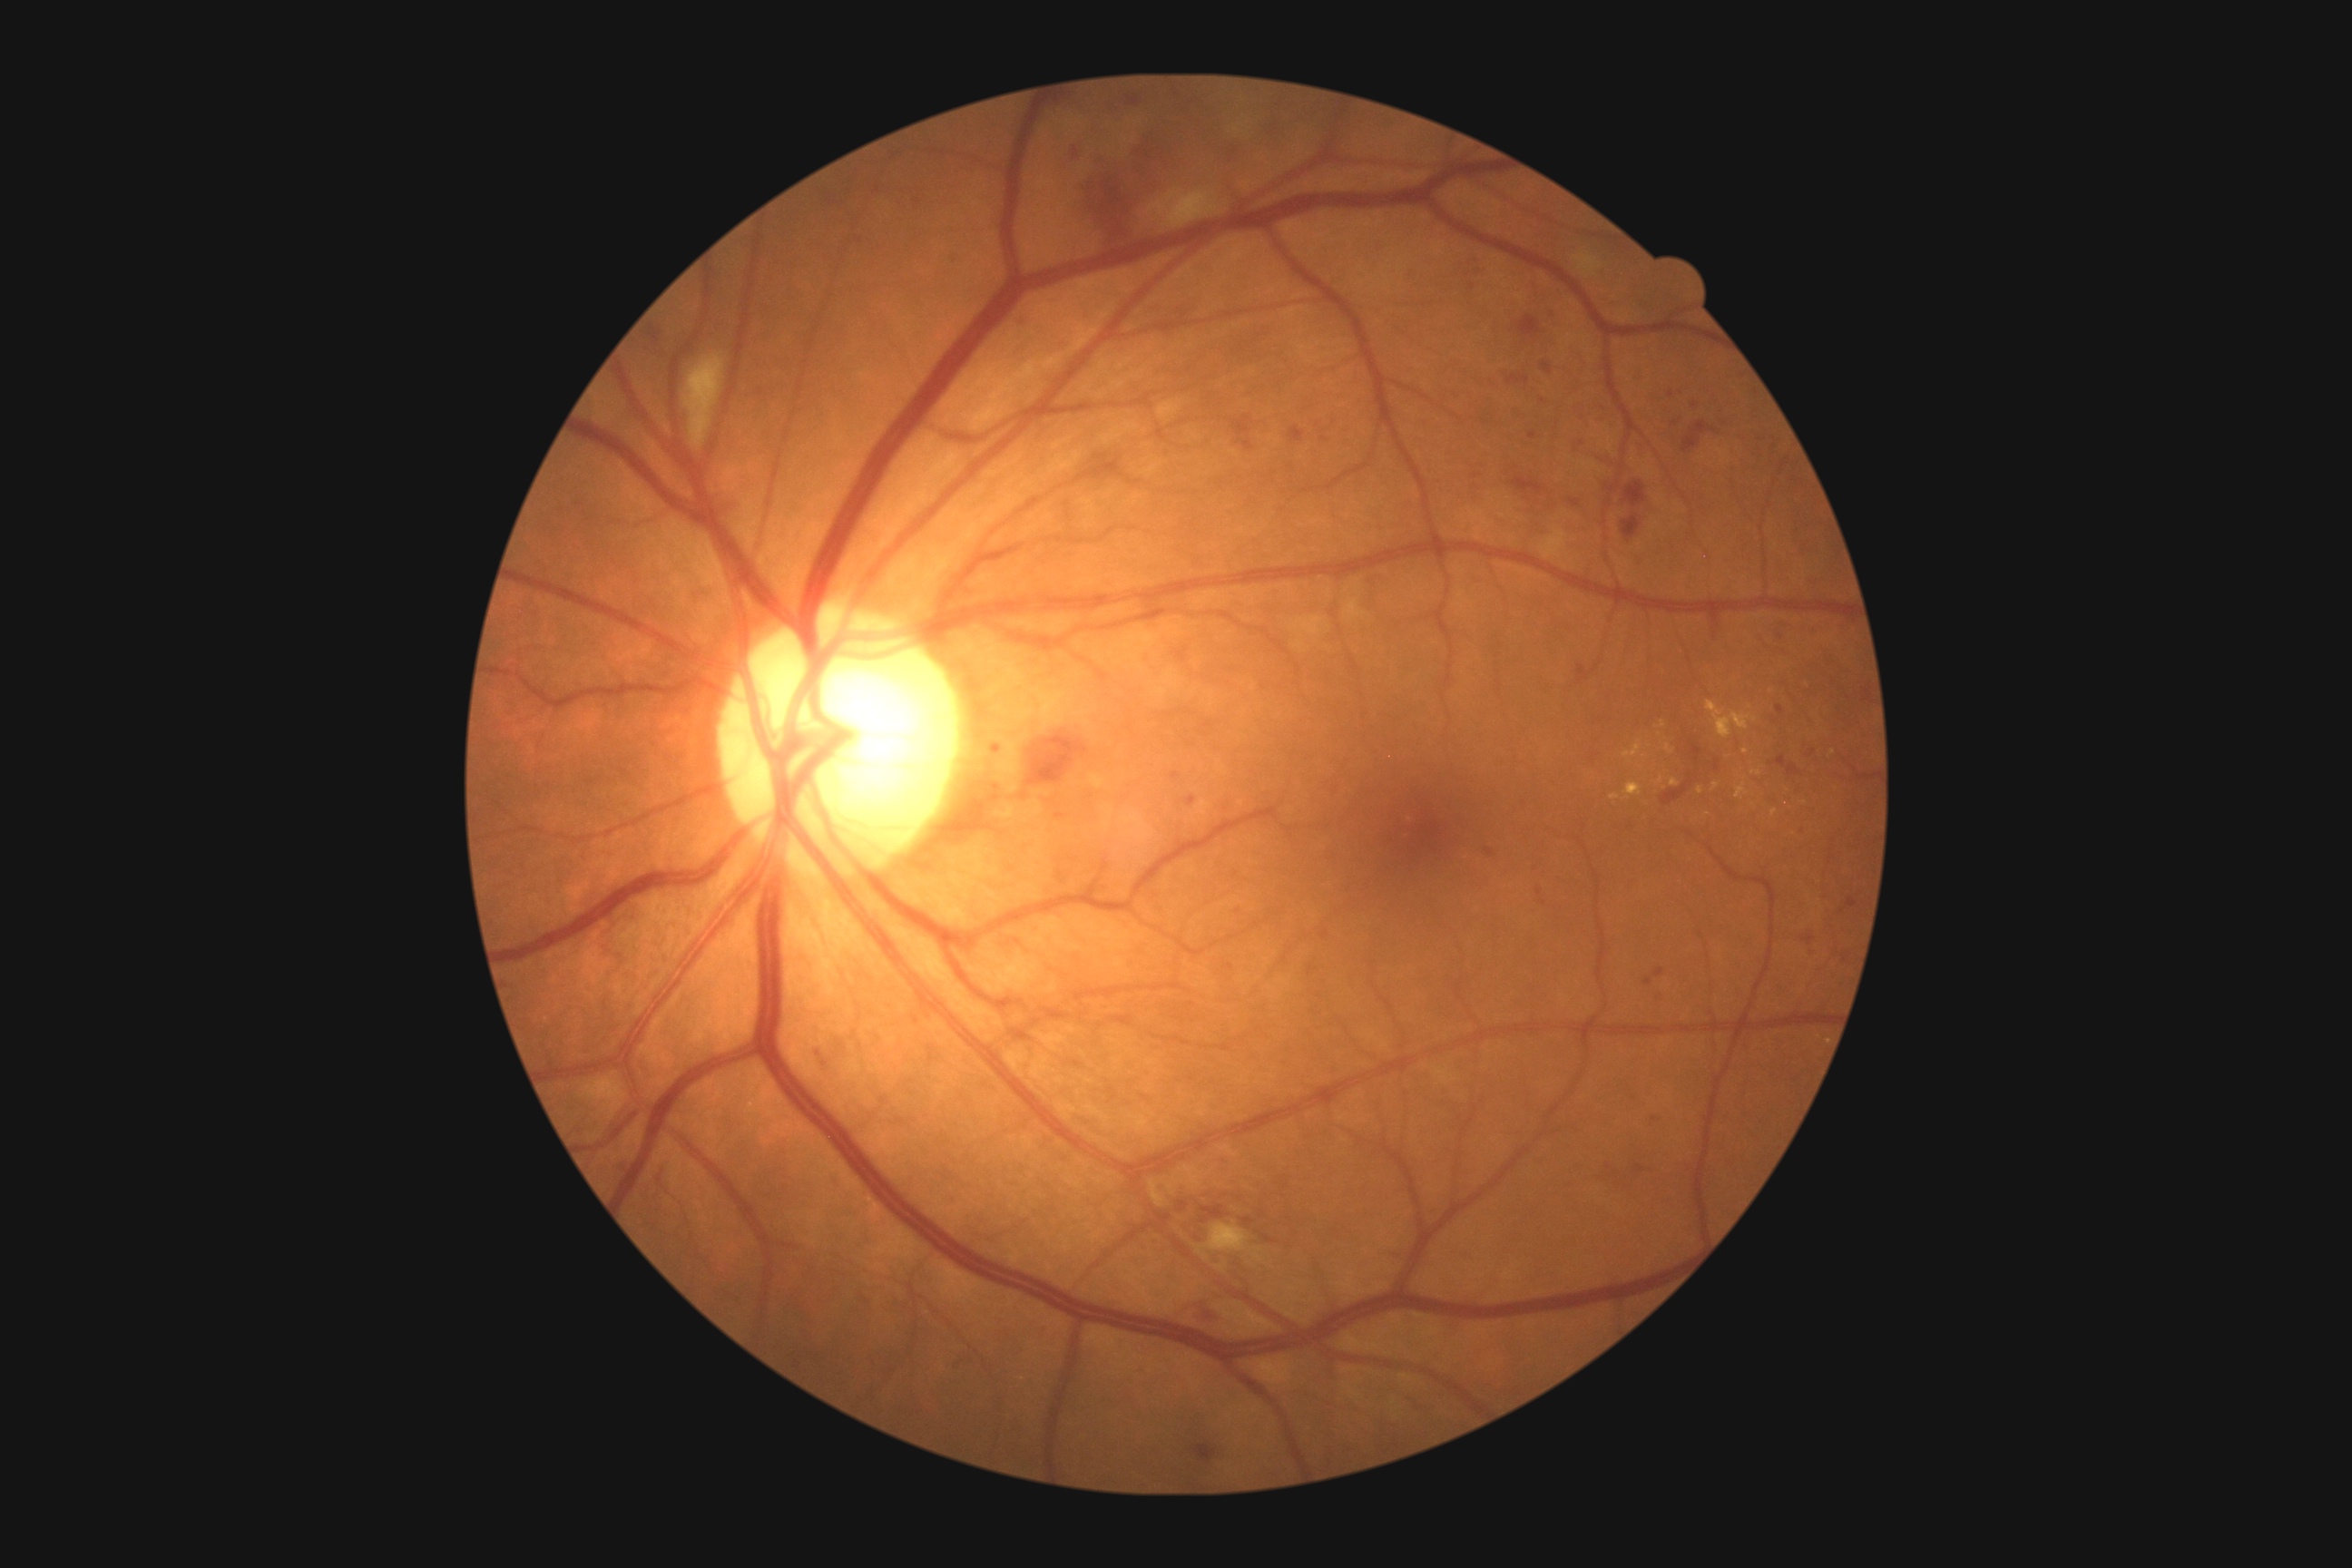
Diabetic retinopathy (DR): grade 2 — more than just microaneurysms but less than severe NPDR.